Wide-field fundus image from infant ROP screening; 640x480px
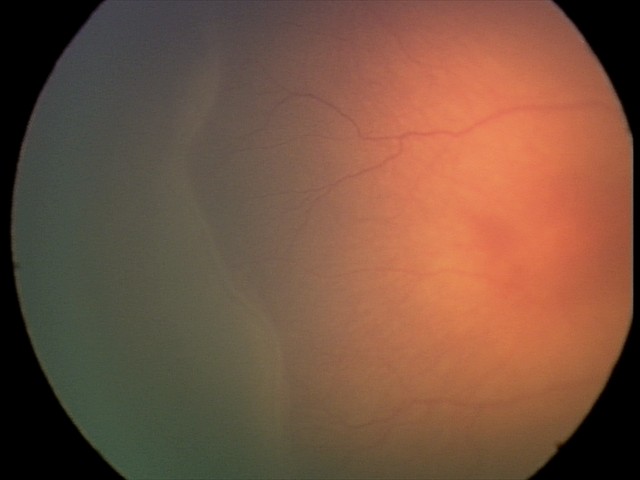 Diagnosis: retinopathy of prematurity (ROP) stage 2.